FOV: 45 degrees: 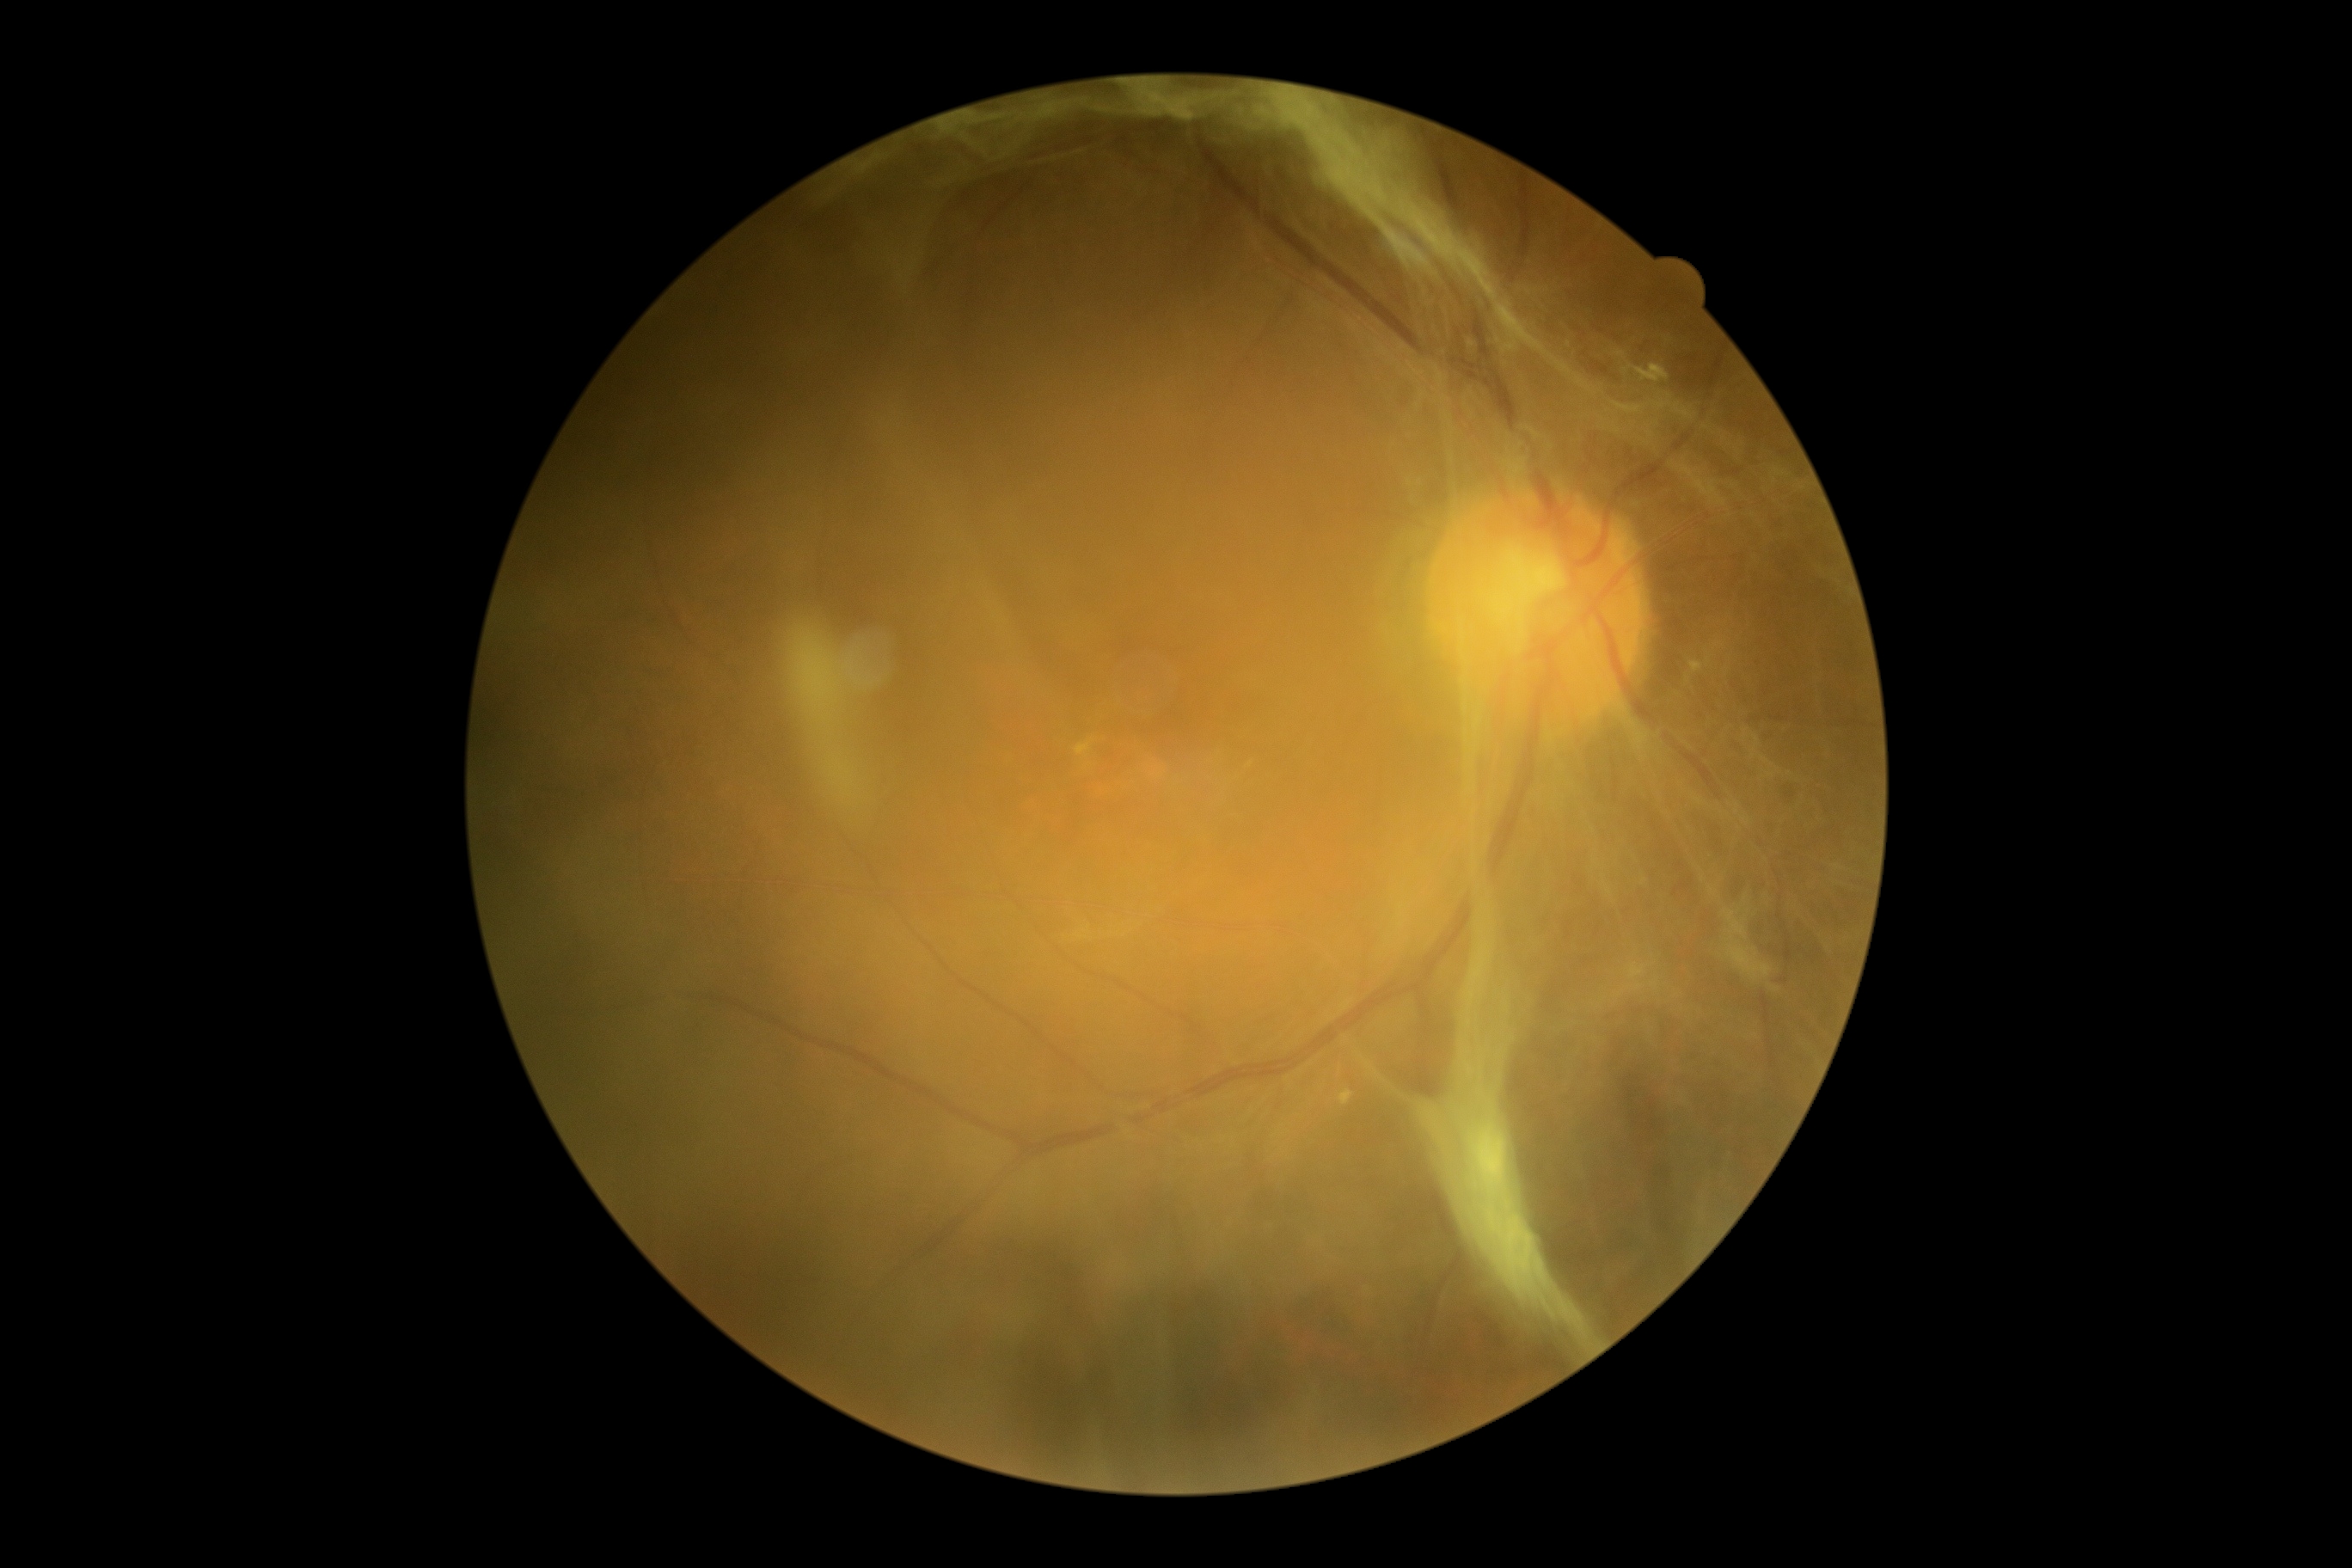

Disease class: proliferative diabetic retinopathy. DR: proliferative diabetic retinopathy (grade 4) — neovascularization and/or vitreous/pre-retinal hemorrhage.